Image size 2352x1568
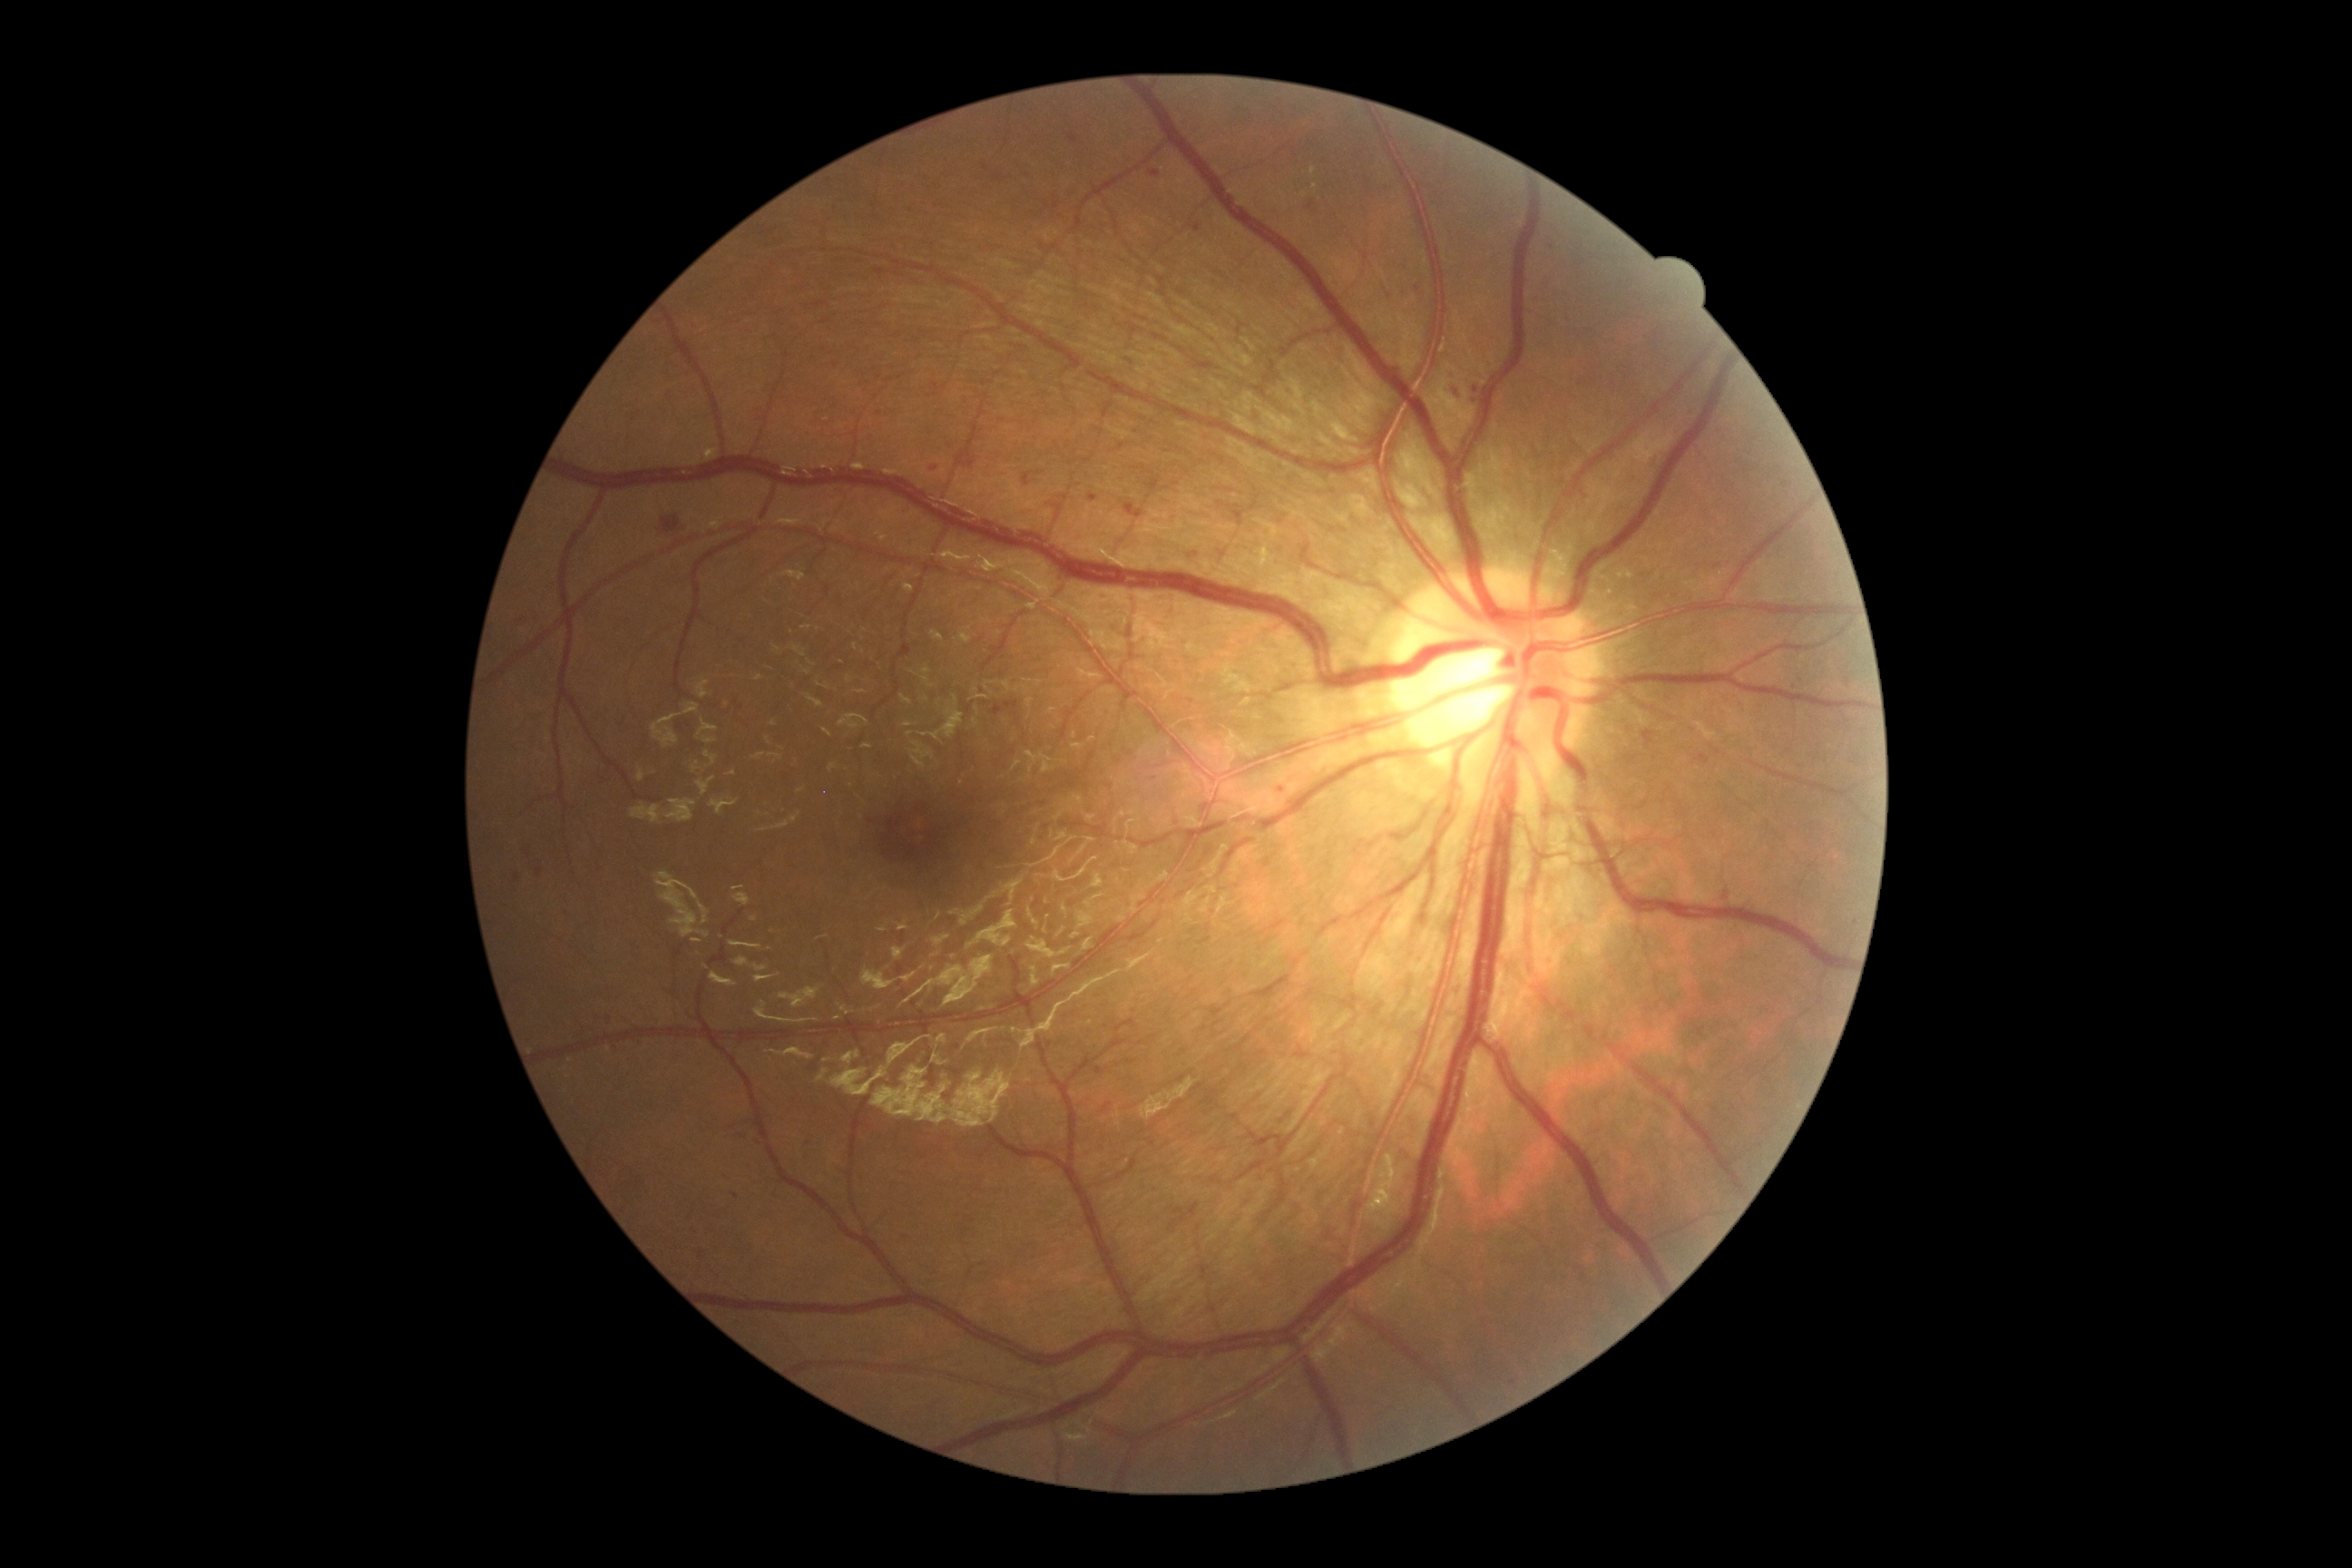

Diabetic retinopathy (DR) is grade 2 (moderate NPDR); non-proliferative diabetic retinopathy
Lesions identified (partial list):
• microaneurysms (MAs) (more not shown): box=[1277, 785, 1289, 796]; box=[867, 819, 877, 825]; box=[514, 874, 522, 885]; box=[738, 1135, 747, 1139]; box=[729, 1124, 738, 1130]; box=[1048, 495, 1068, 520]; box=[1841, 665, 1852, 687]; box=[732, 1191, 740, 1200]; box=[1720, 890, 1734, 905]; box=[536, 861, 544, 877]; box=[1148, 170, 1161, 179]; box=[1184, 219, 1202, 233]
• Small MAs approximately at [1417,288]; [758,1143]